45° field of view: 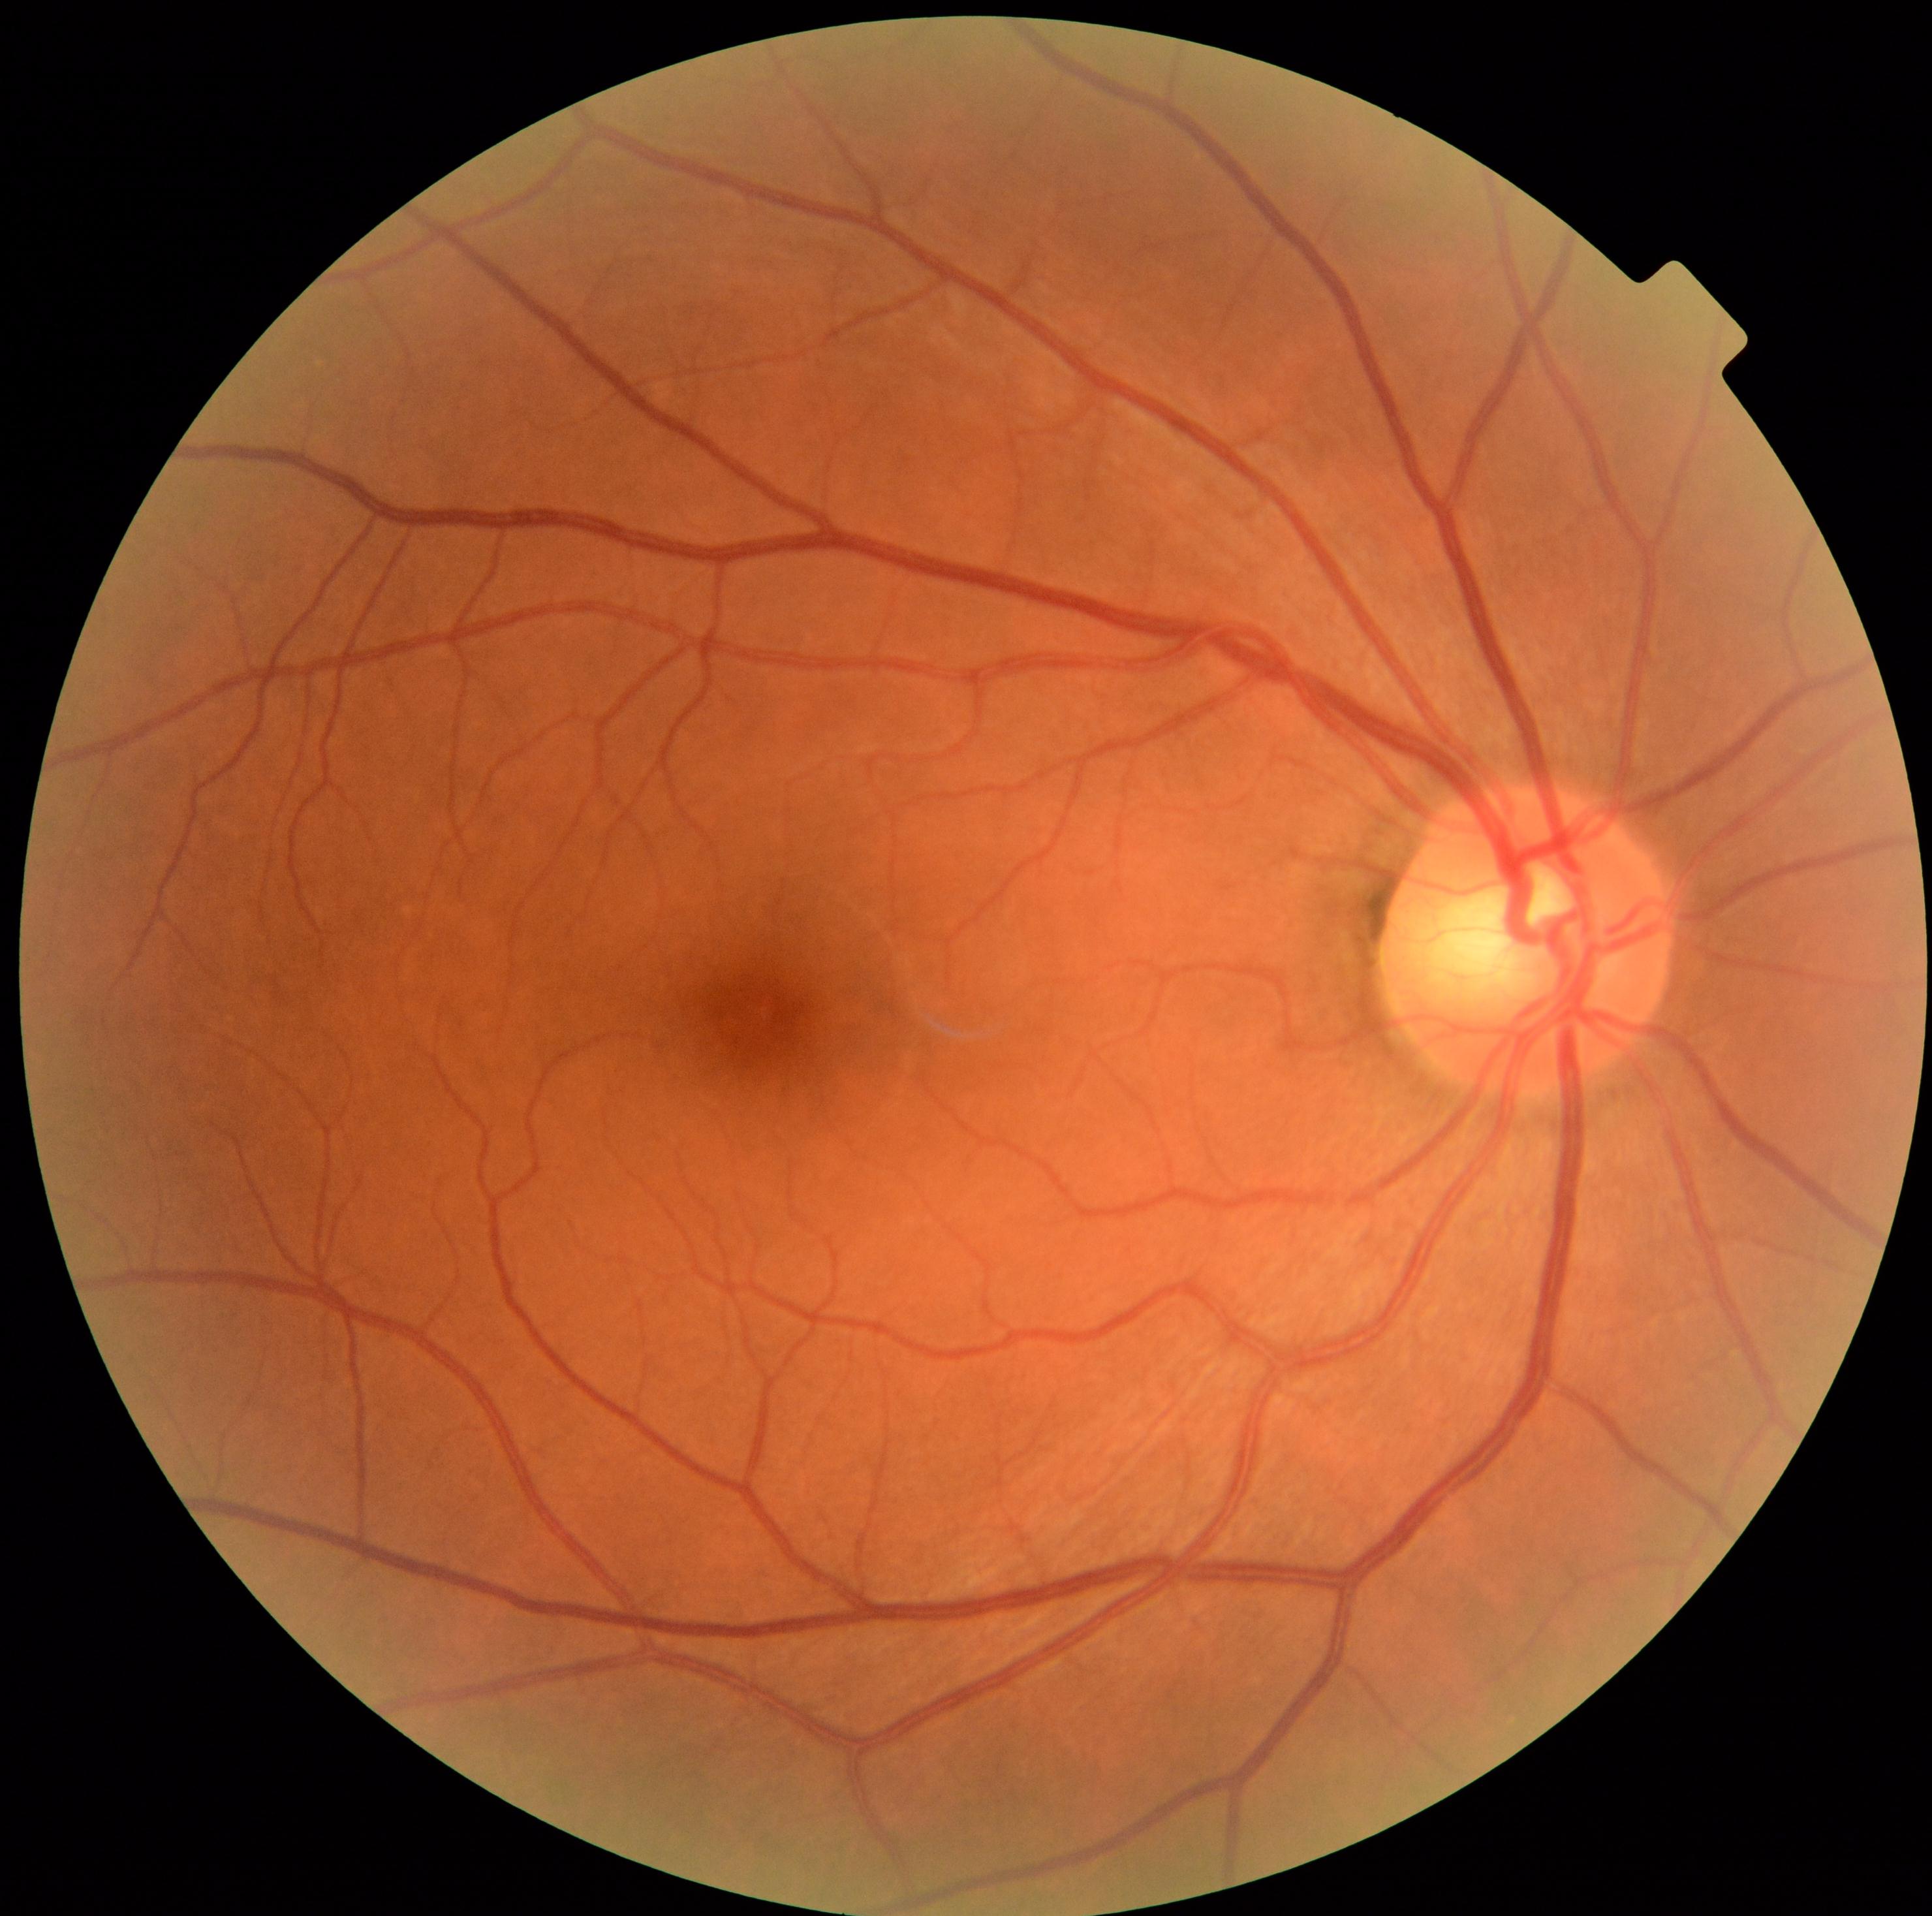
DR stage is no apparent retinopathy (grade 0).